Acquired on the Phoenix ICON · wide-field fundus photograph of an infant — 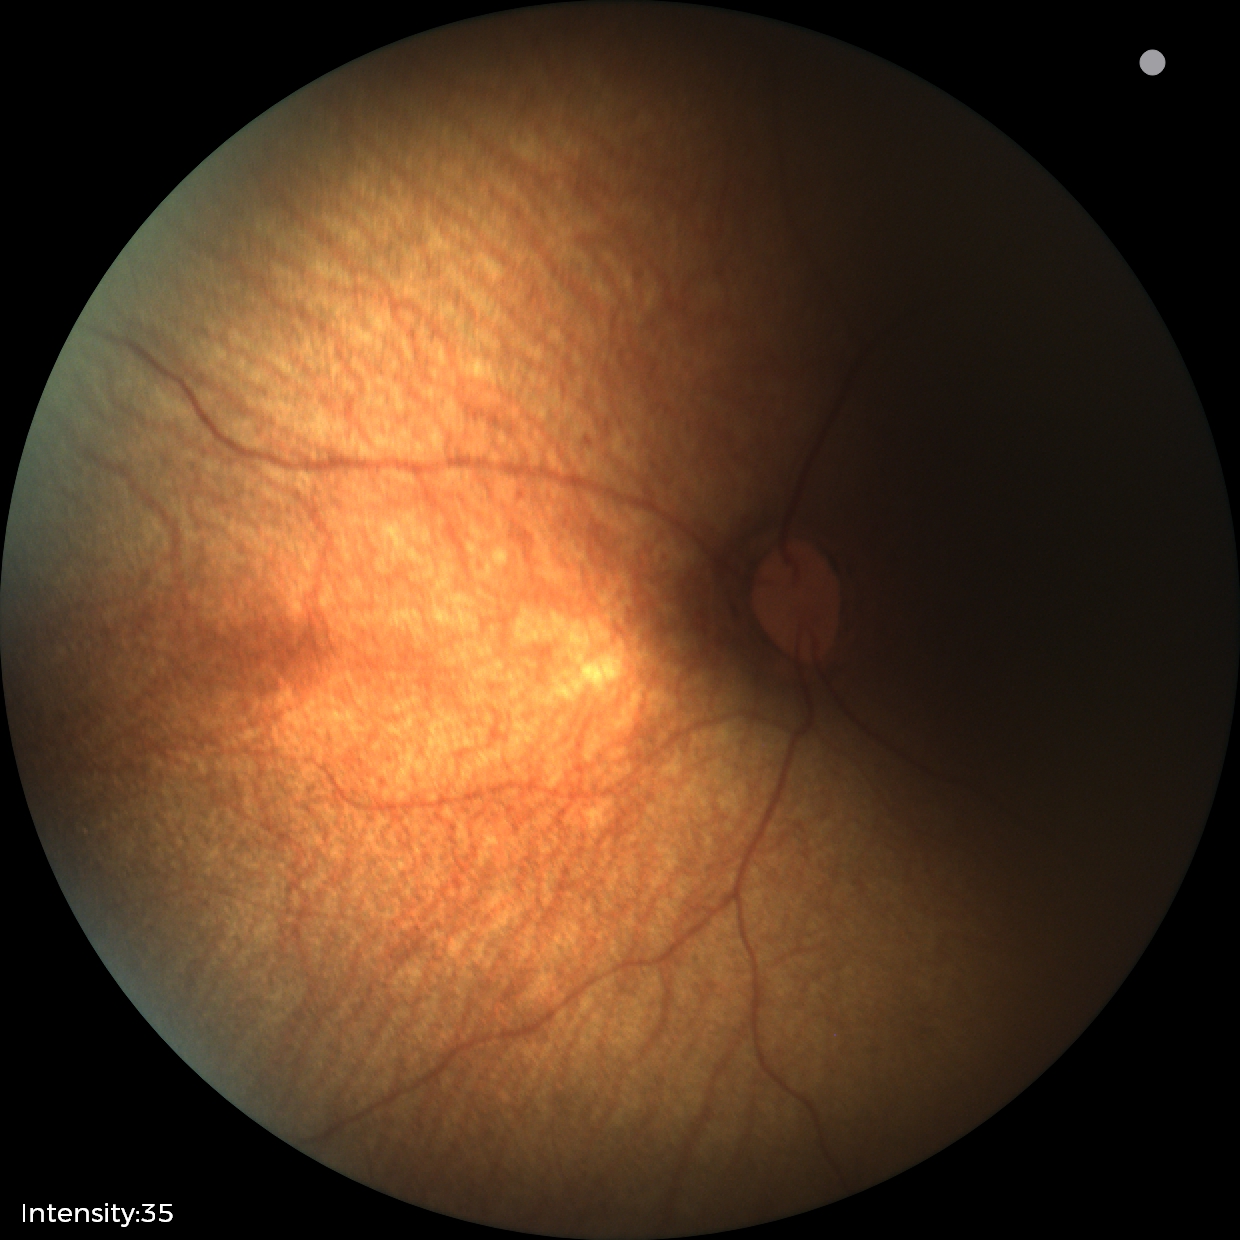

Impression = physiological.